848x848px, nonmydriatic fundus photograph, posterior pole photograph, 45° field of view: 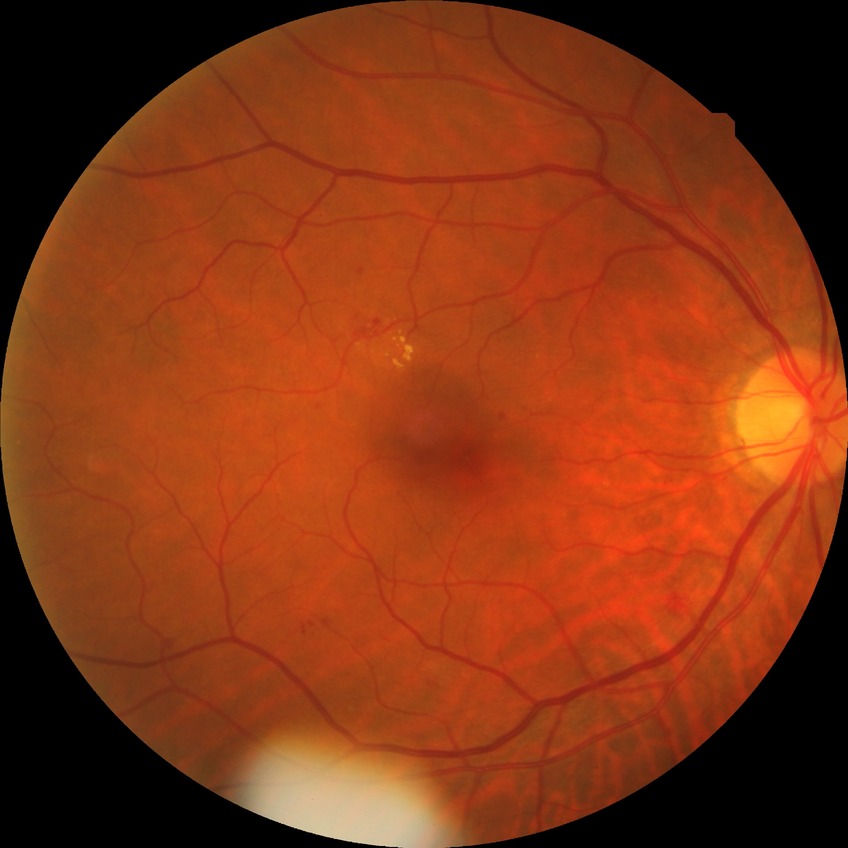 diabetic retinopathy (DR)=SDR (simple diabetic retinopathy).